1659 by 2212 pixels; color fundus photograph — 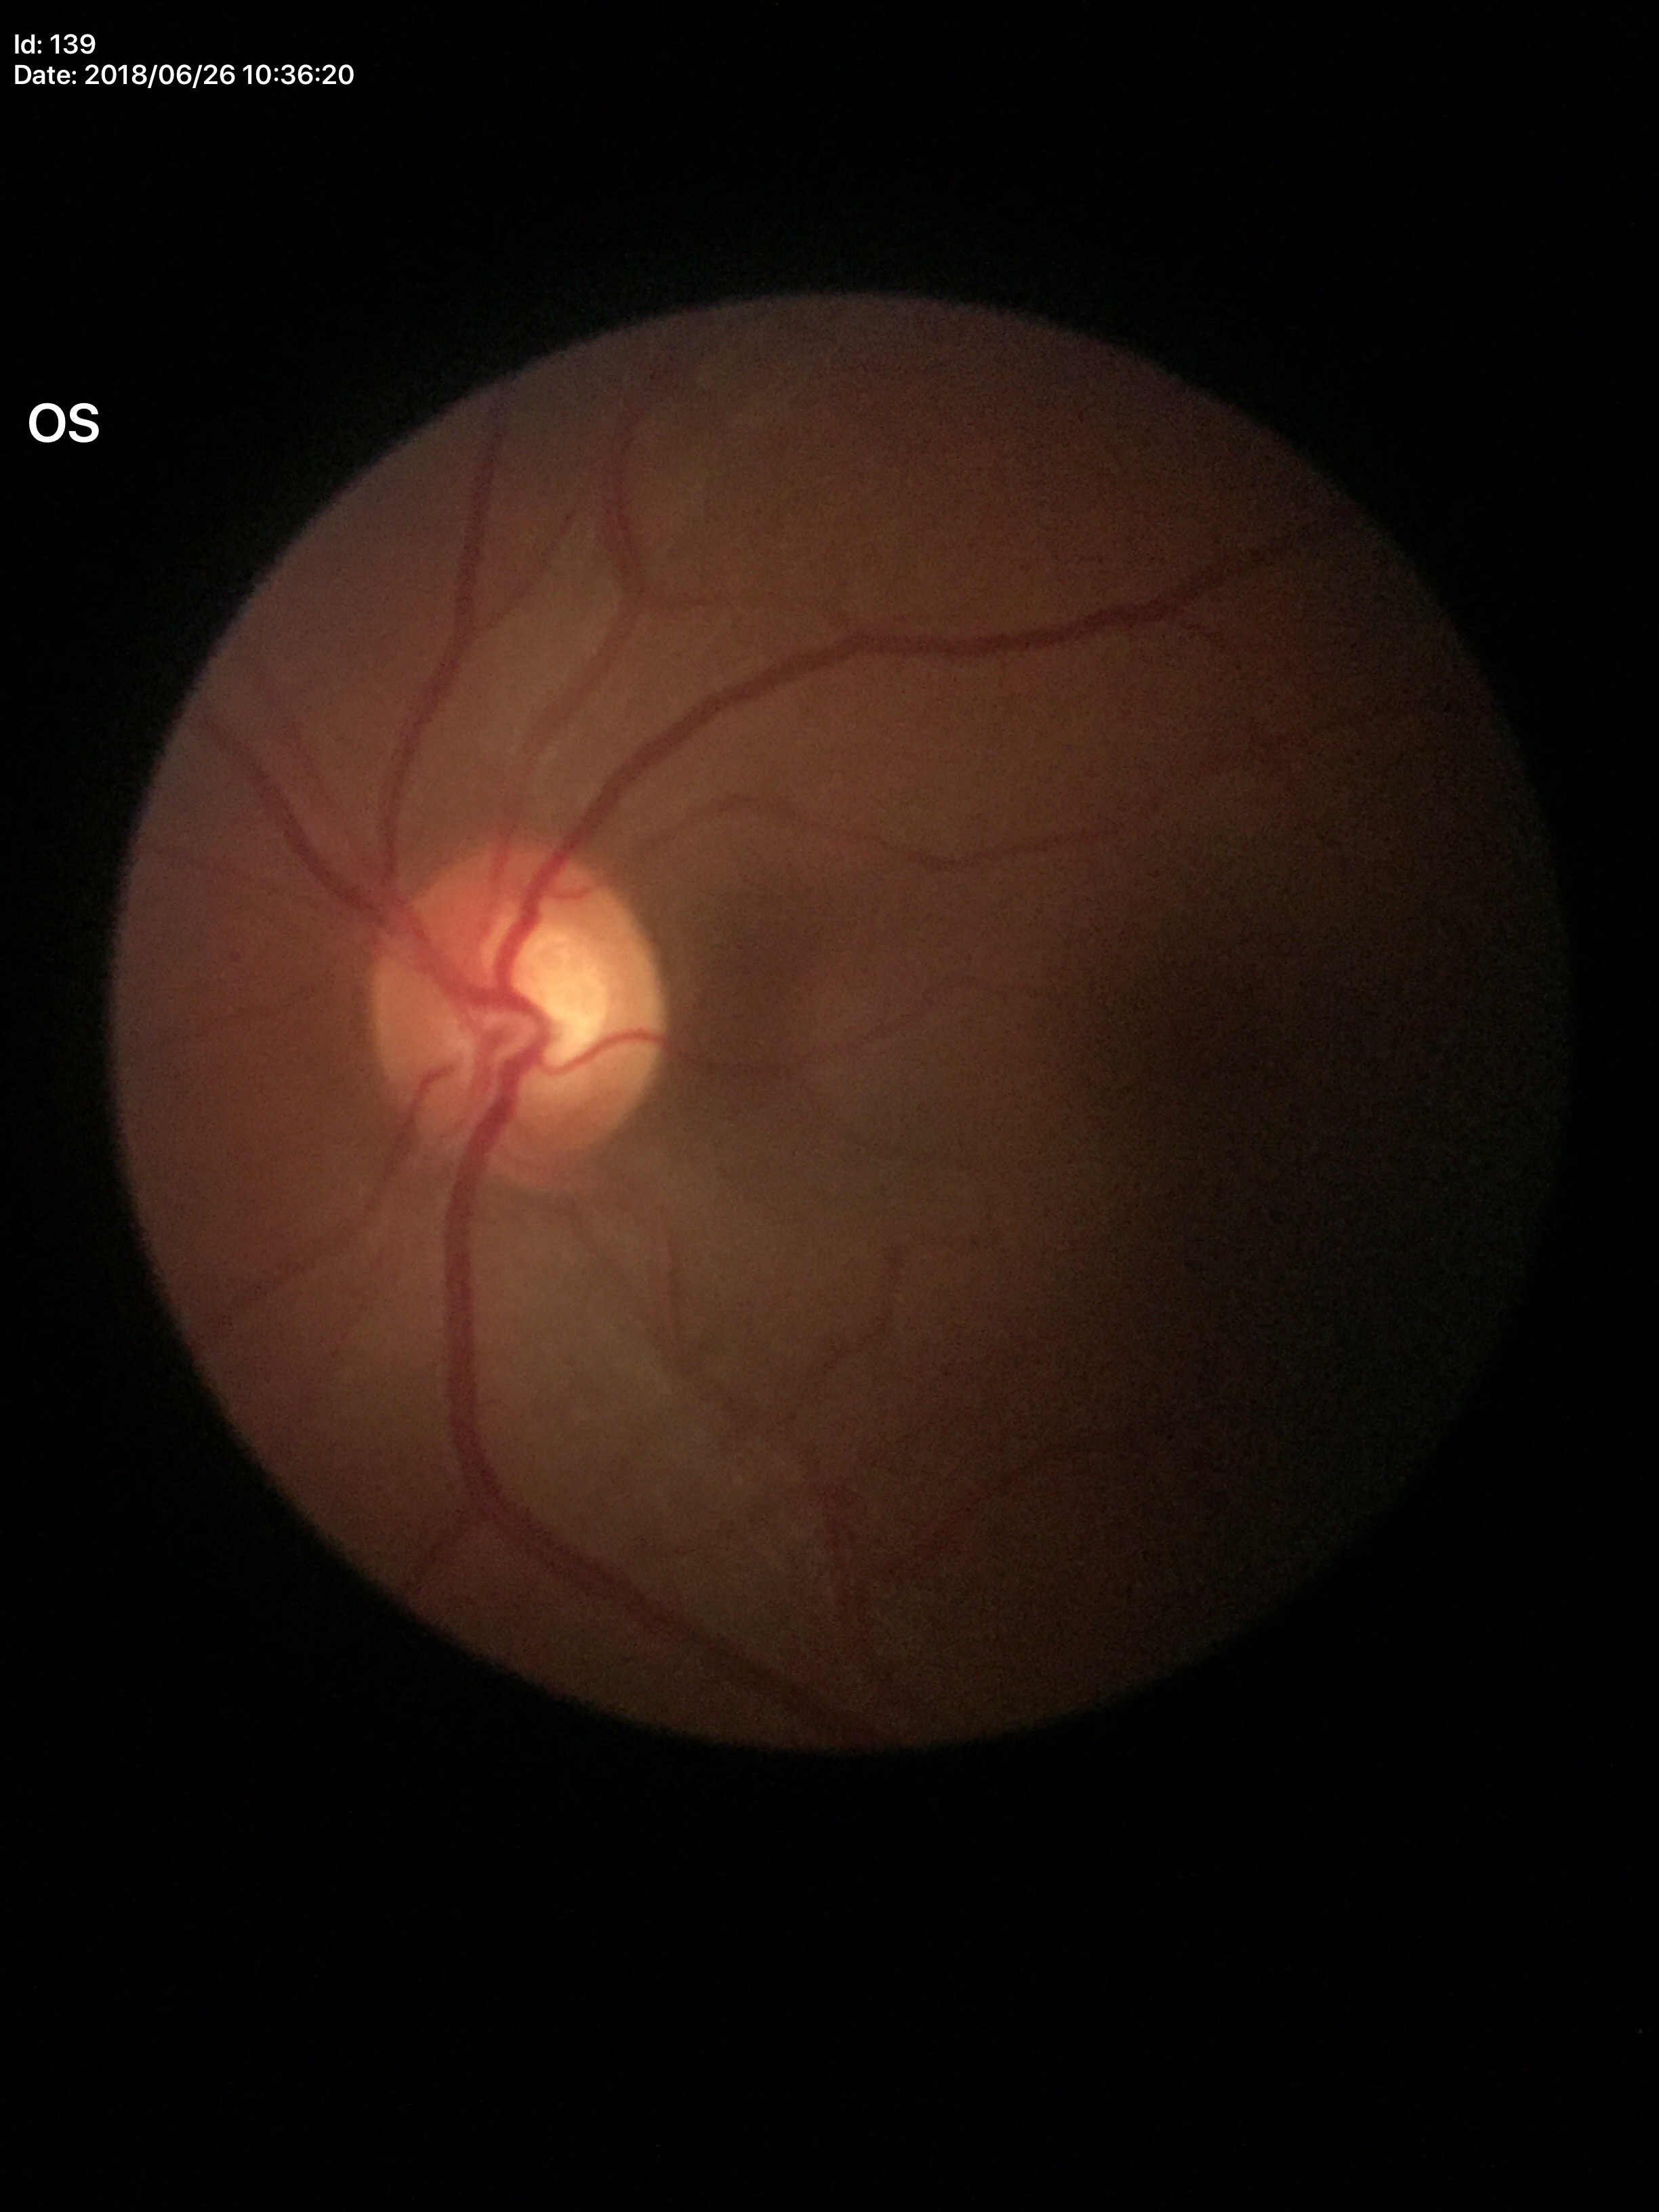 – Glaucoma screening impression — negative
– vertical C/D ratio (VCDR) — 0.58
– horizontal C/D ratio (HCDR) — 0.59
– area CDR (ACDR) — 0.34